2212x1659px
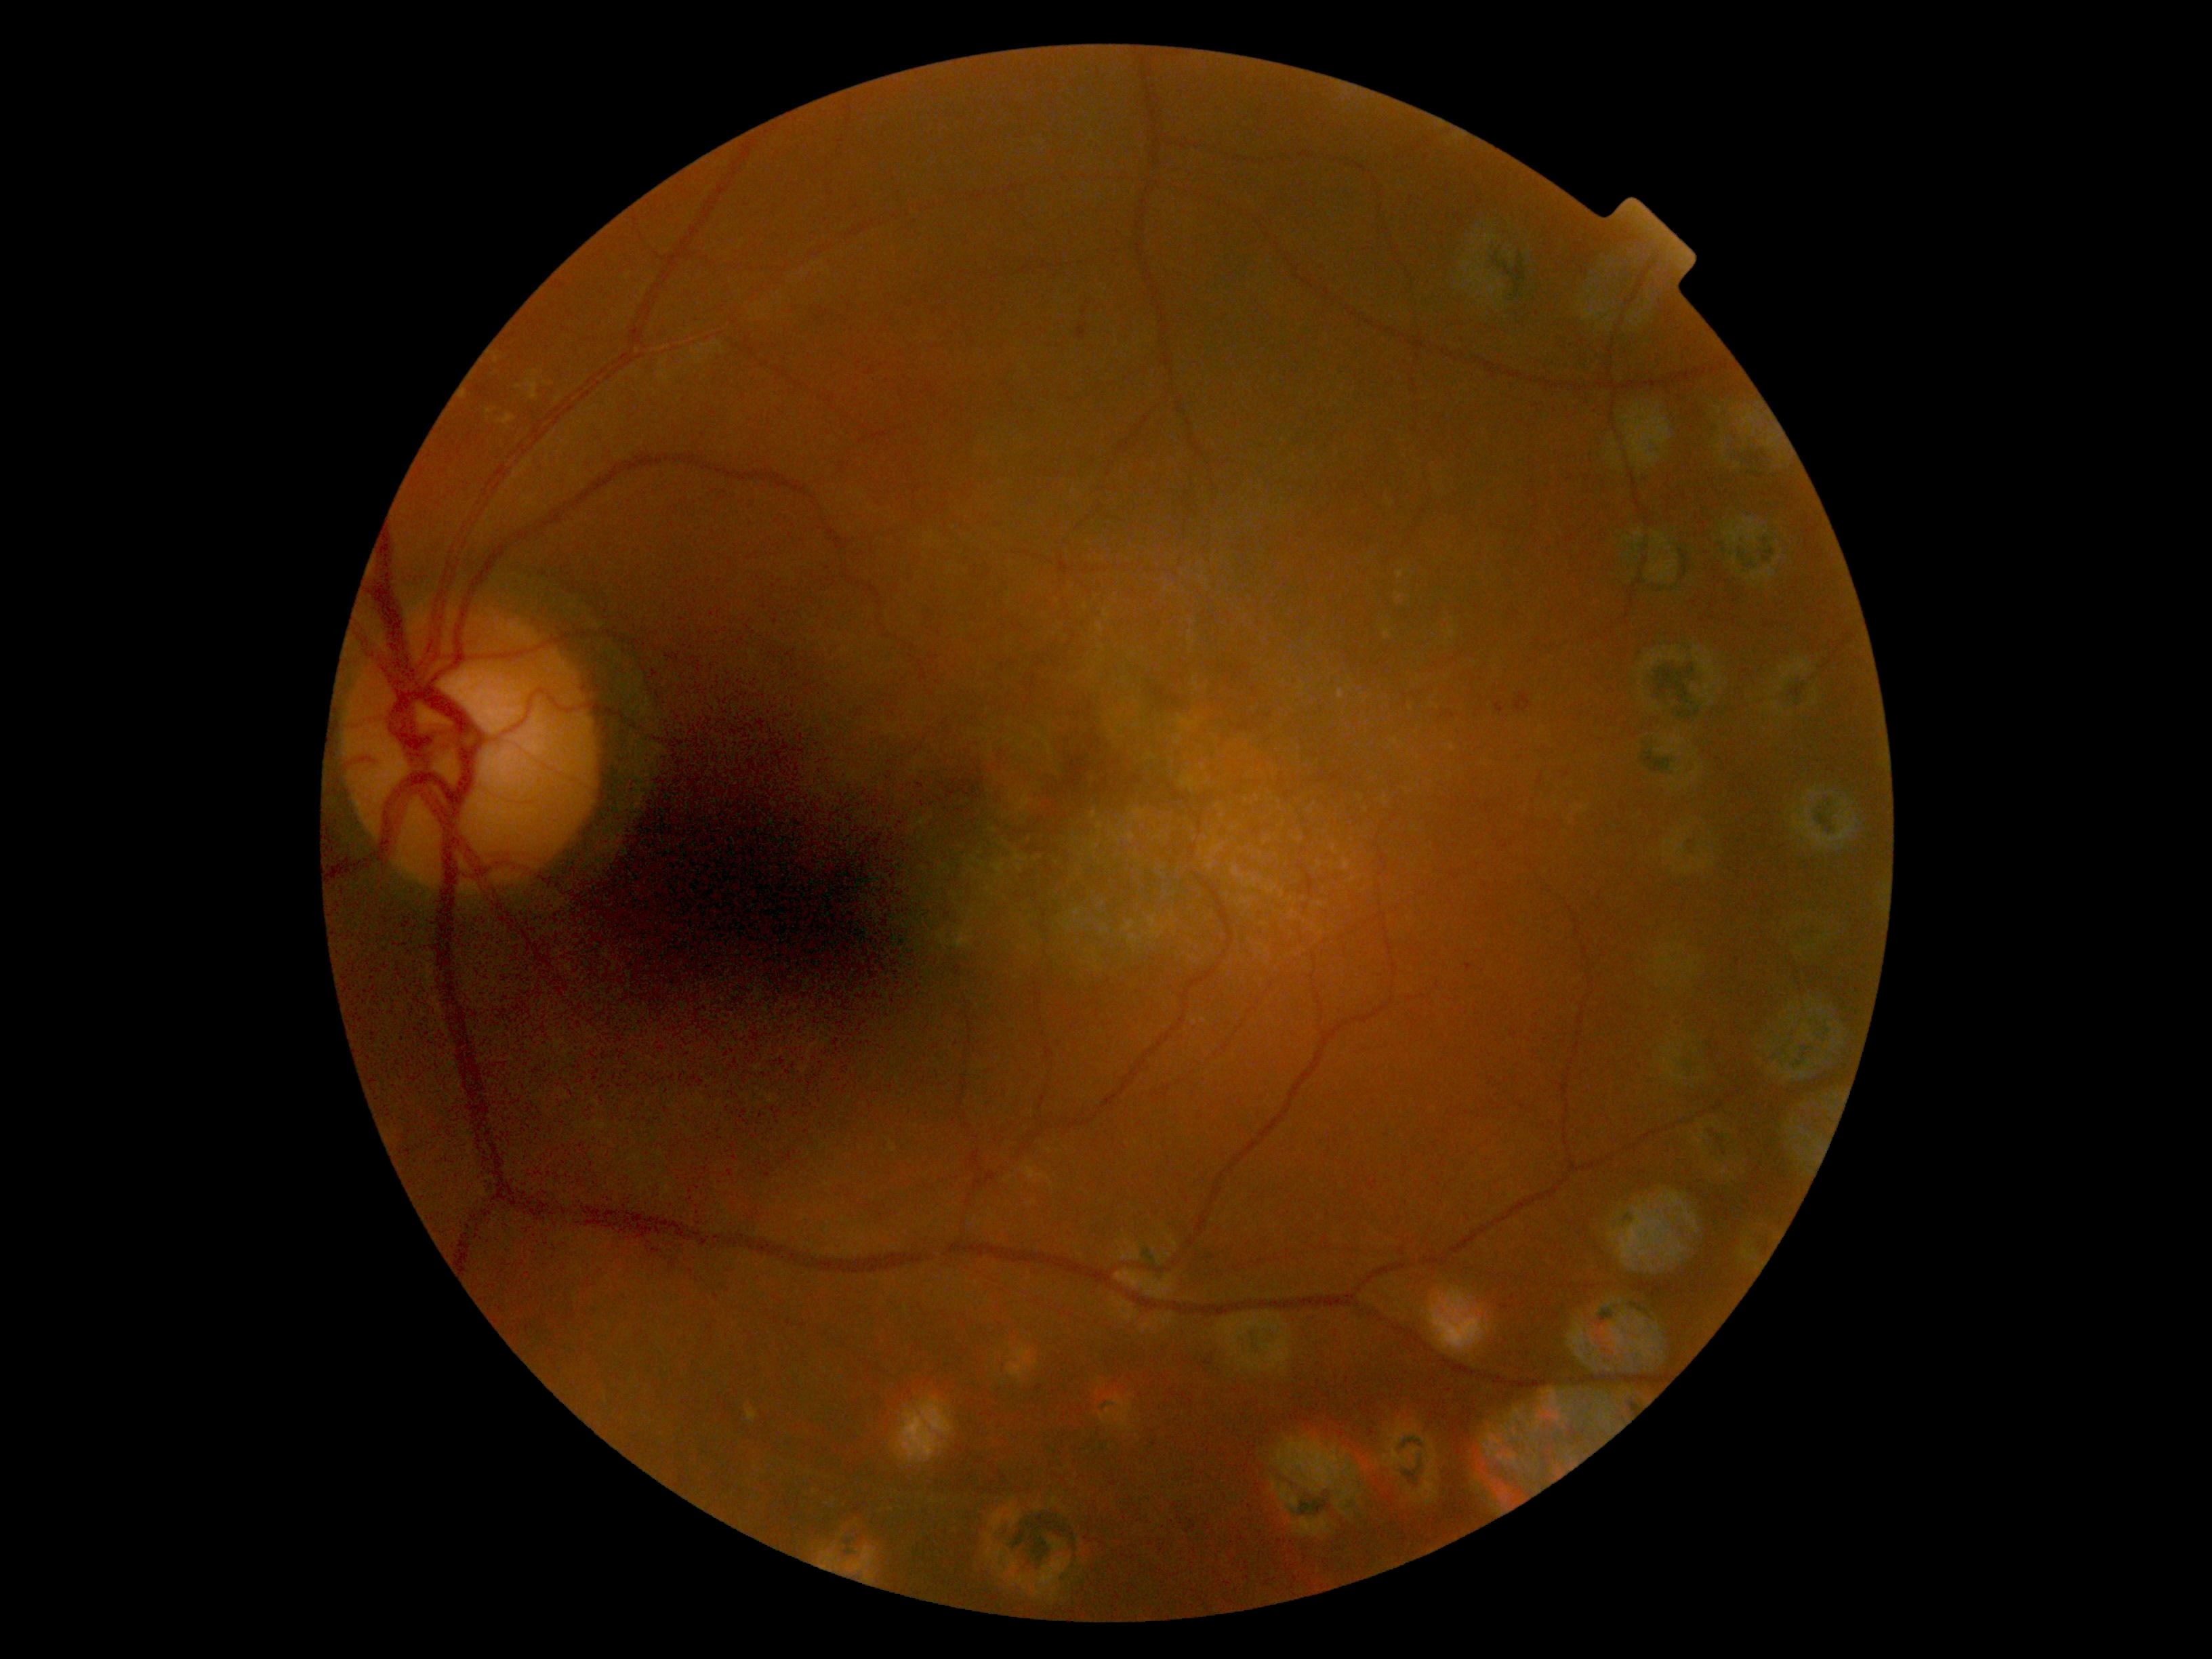 Diabetic retinopathy (DR) is moderate NPDR (grade 2).